50° FOV; fundus photo
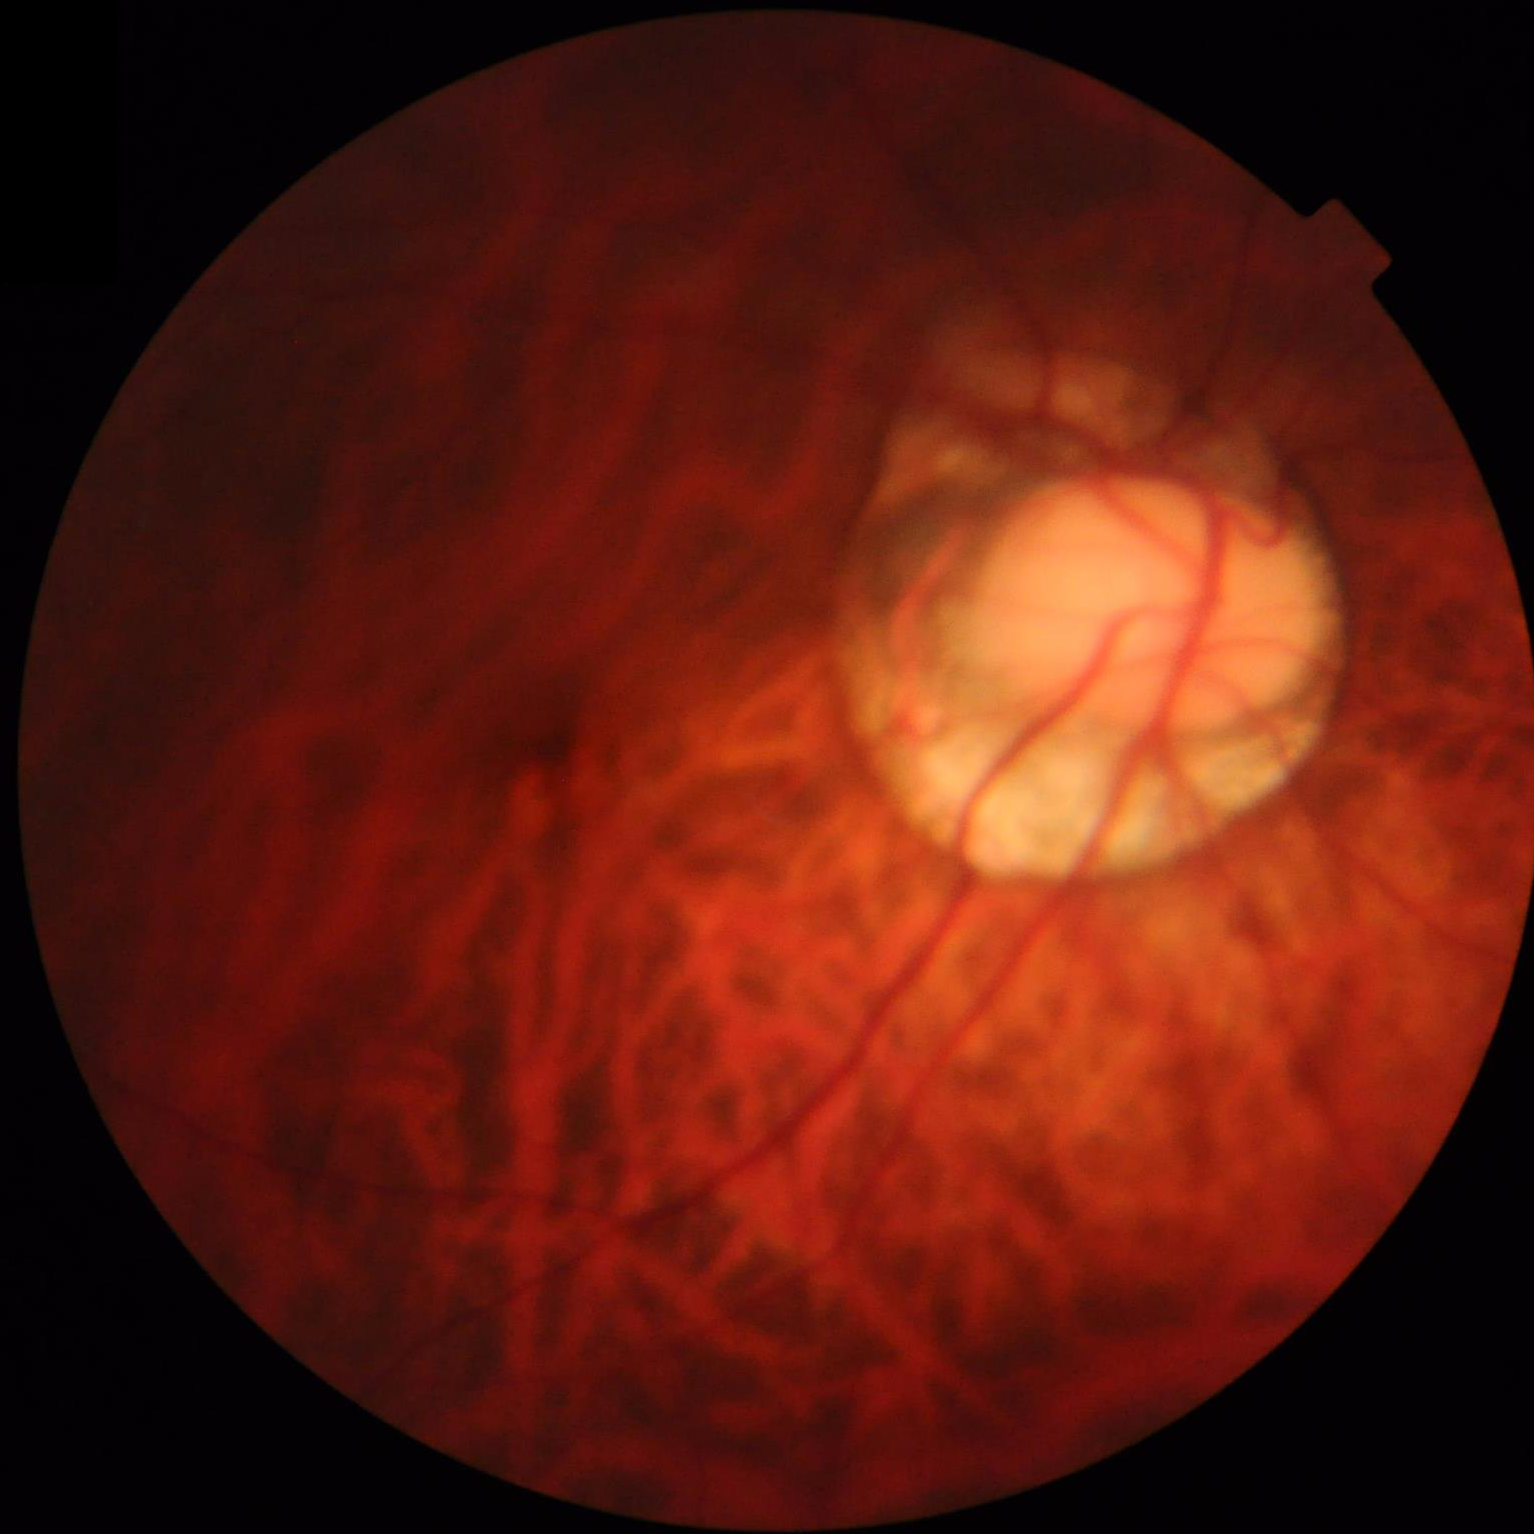
Image quality is suboptimal. Poor illumination with uneven exposure. Contrast is good. Optic disc, vessels, and background are in focus.